2212x1659px · 45° FOV.
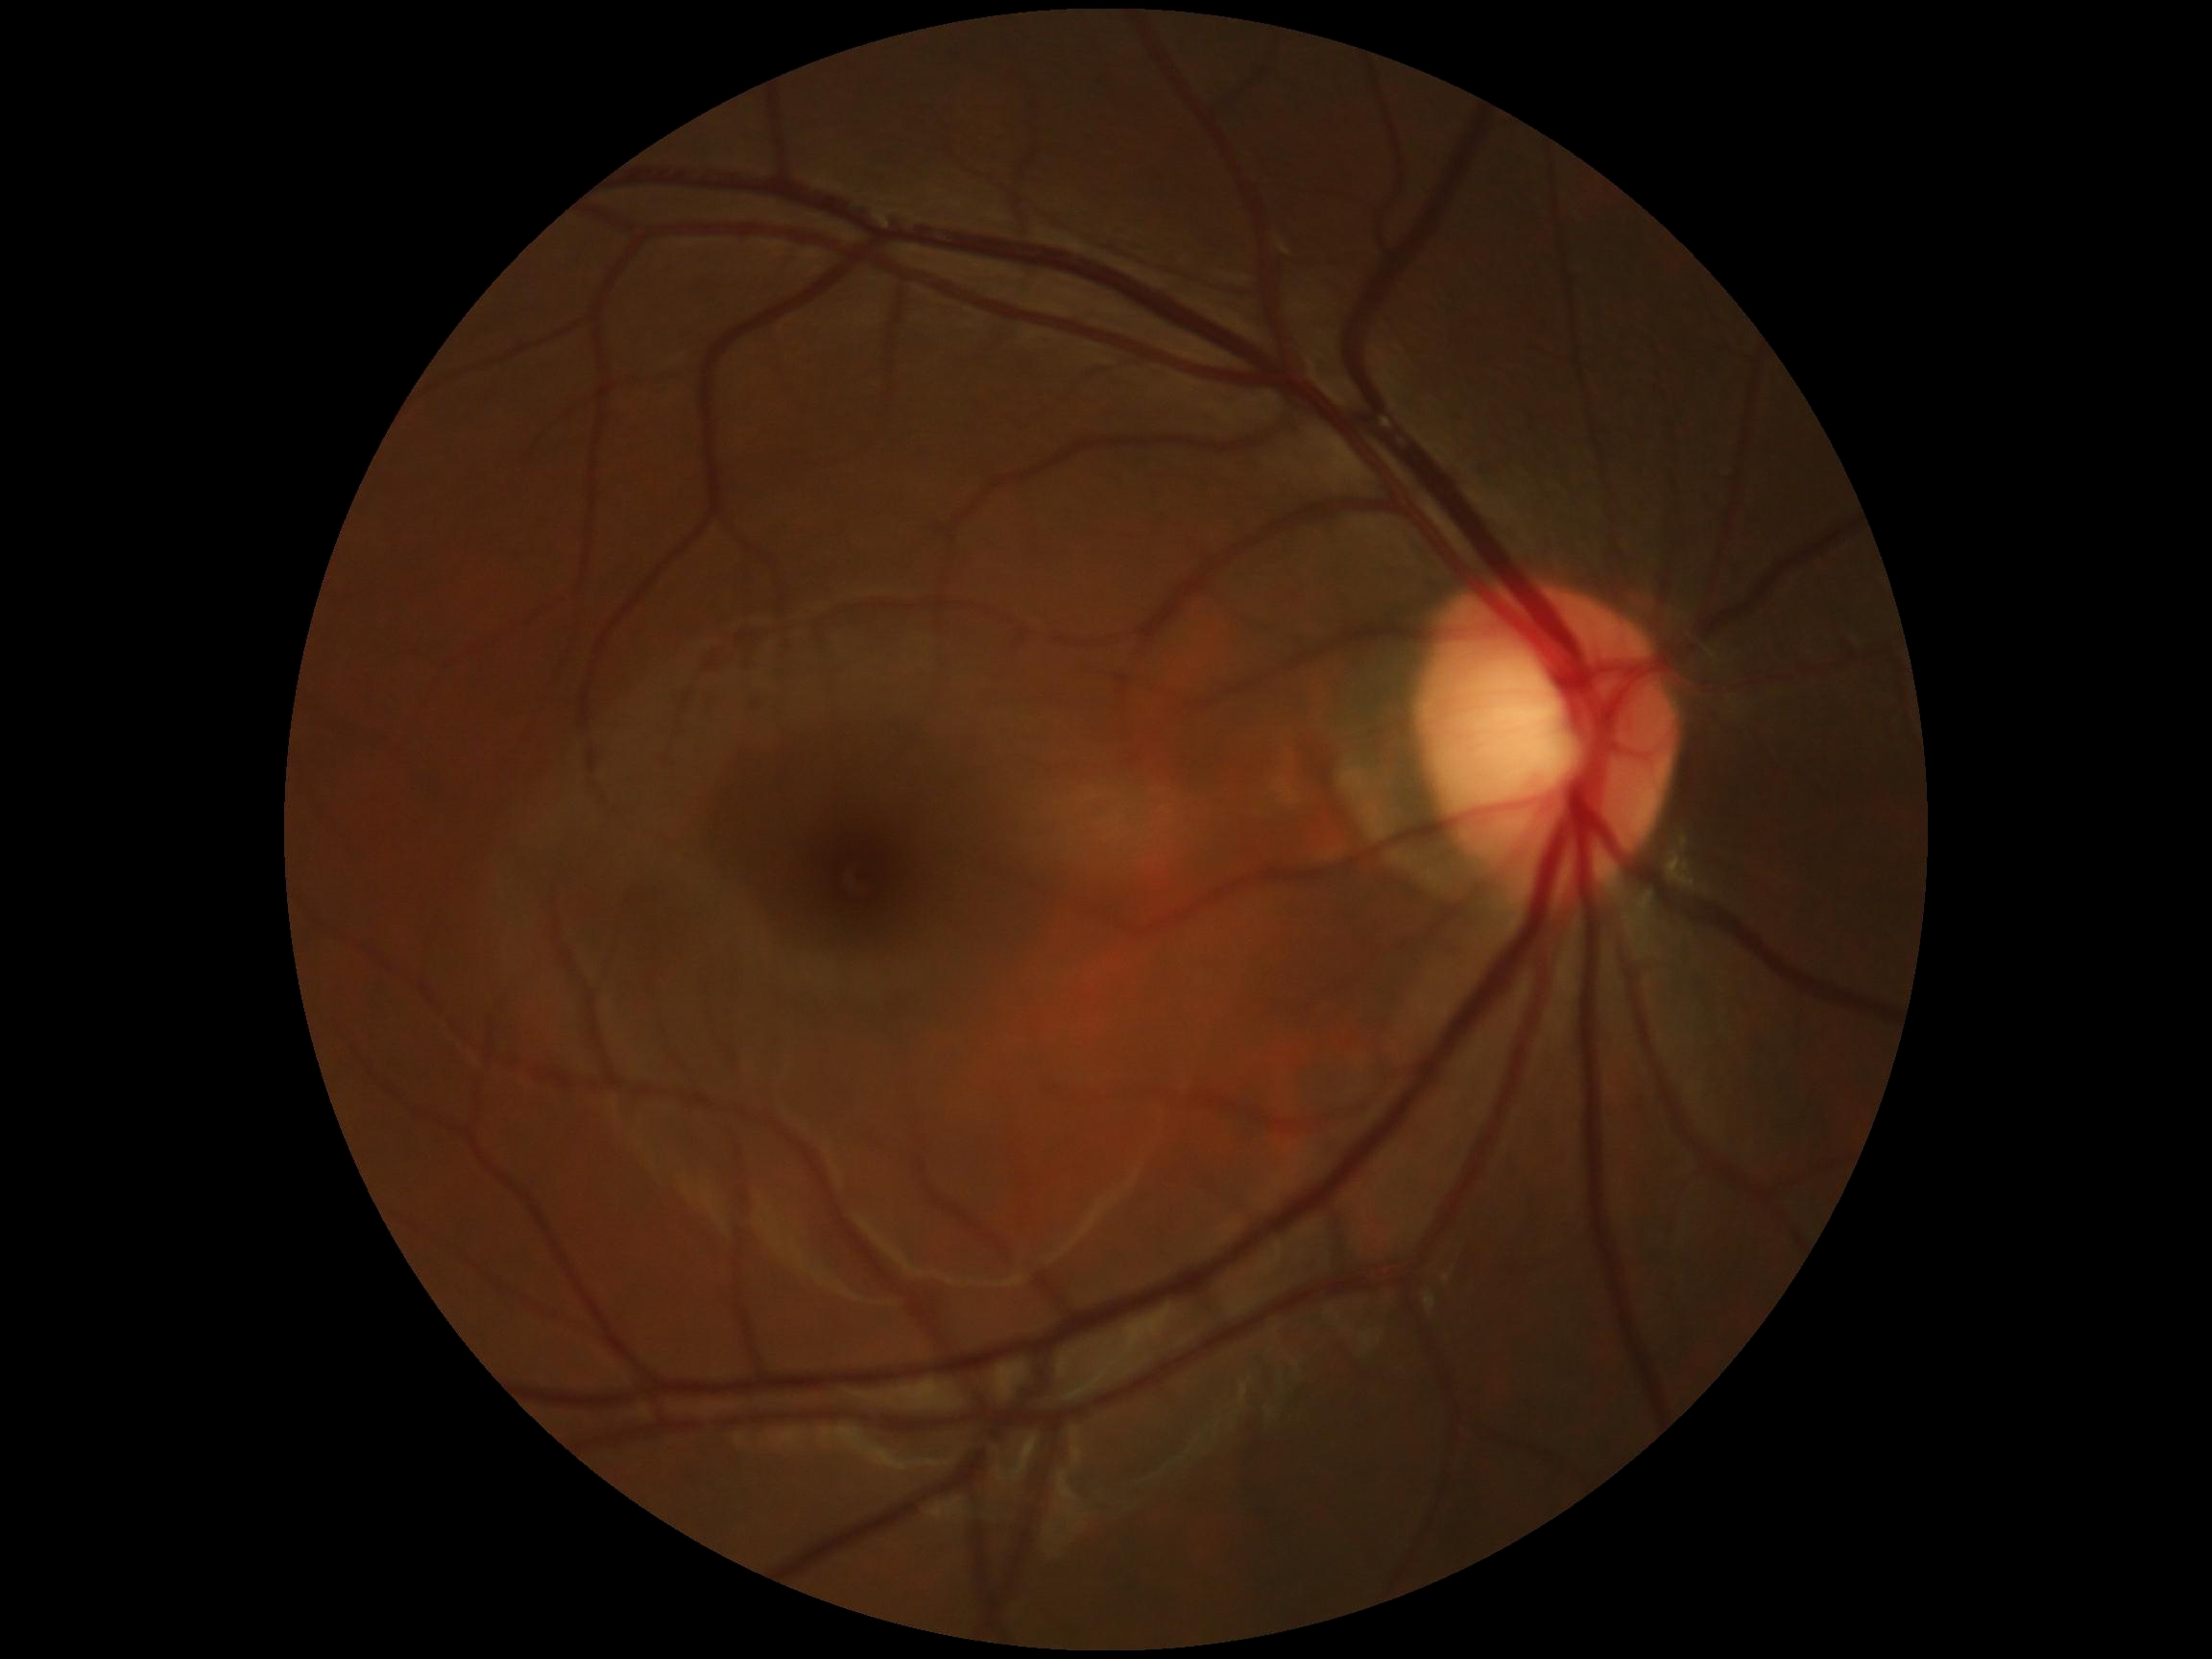 Diabetic retinopathy (DR): no apparent retinopathy (grade 0).